Modified Davis classification.
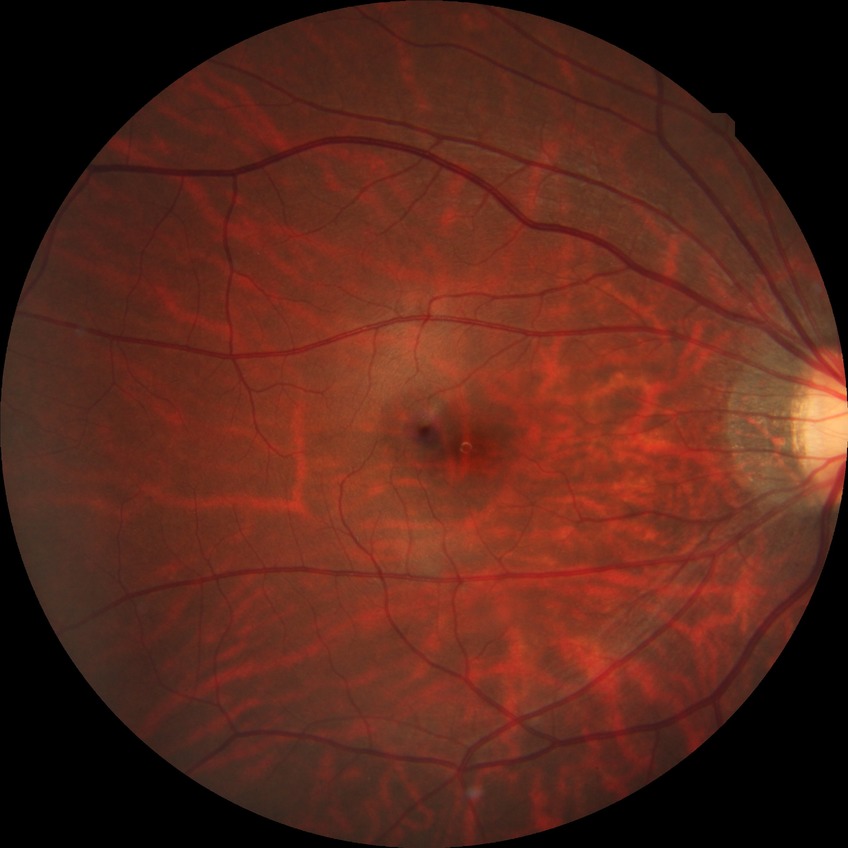 Diabetic retinopathy (DR) is NDR (no diabetic retinopathy).